Fundus photo; centered on the macula; 2361x1568px; dilated-pupil acquisition; FOV: 50 degrees
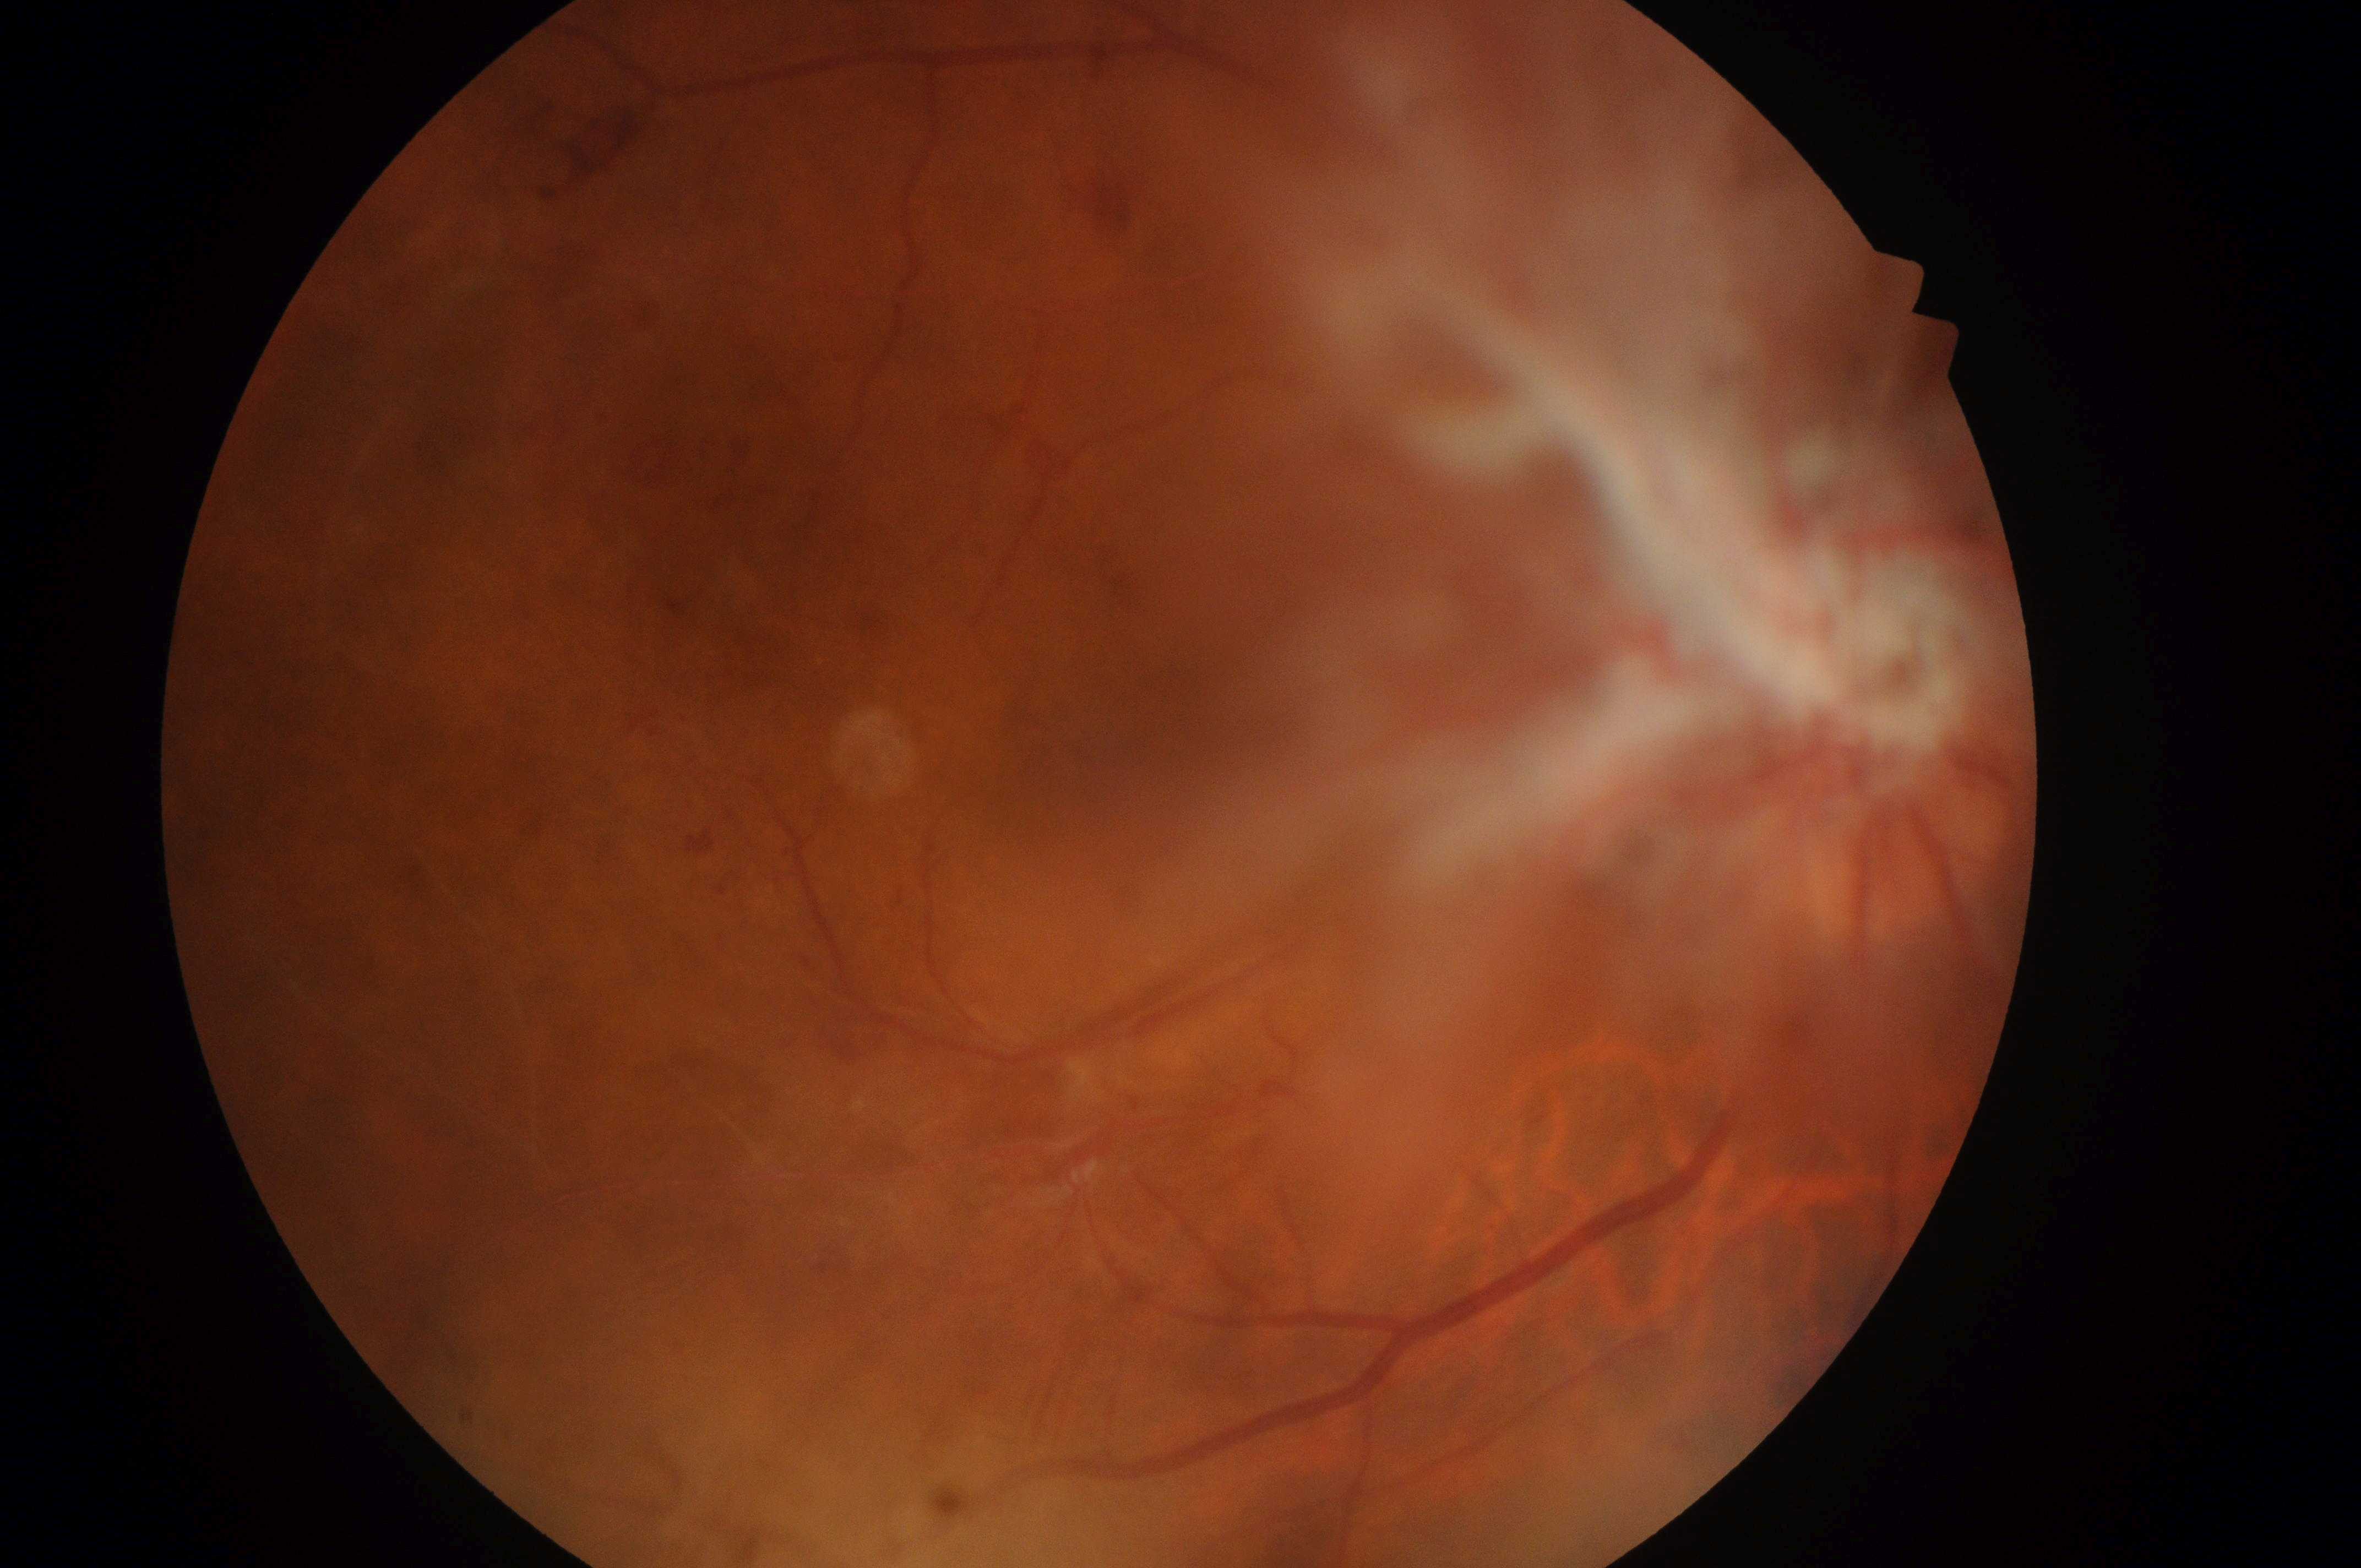

| field | value |
|---|---|
| eye | OD |
| DR stage | proliferative diabetic retinopathy (grade 4) |
| DME | no risk (grade 0) |
| the fovea | (x: 1136, y: 748) |
| optic disc center | (x: 1883, y: 777) |